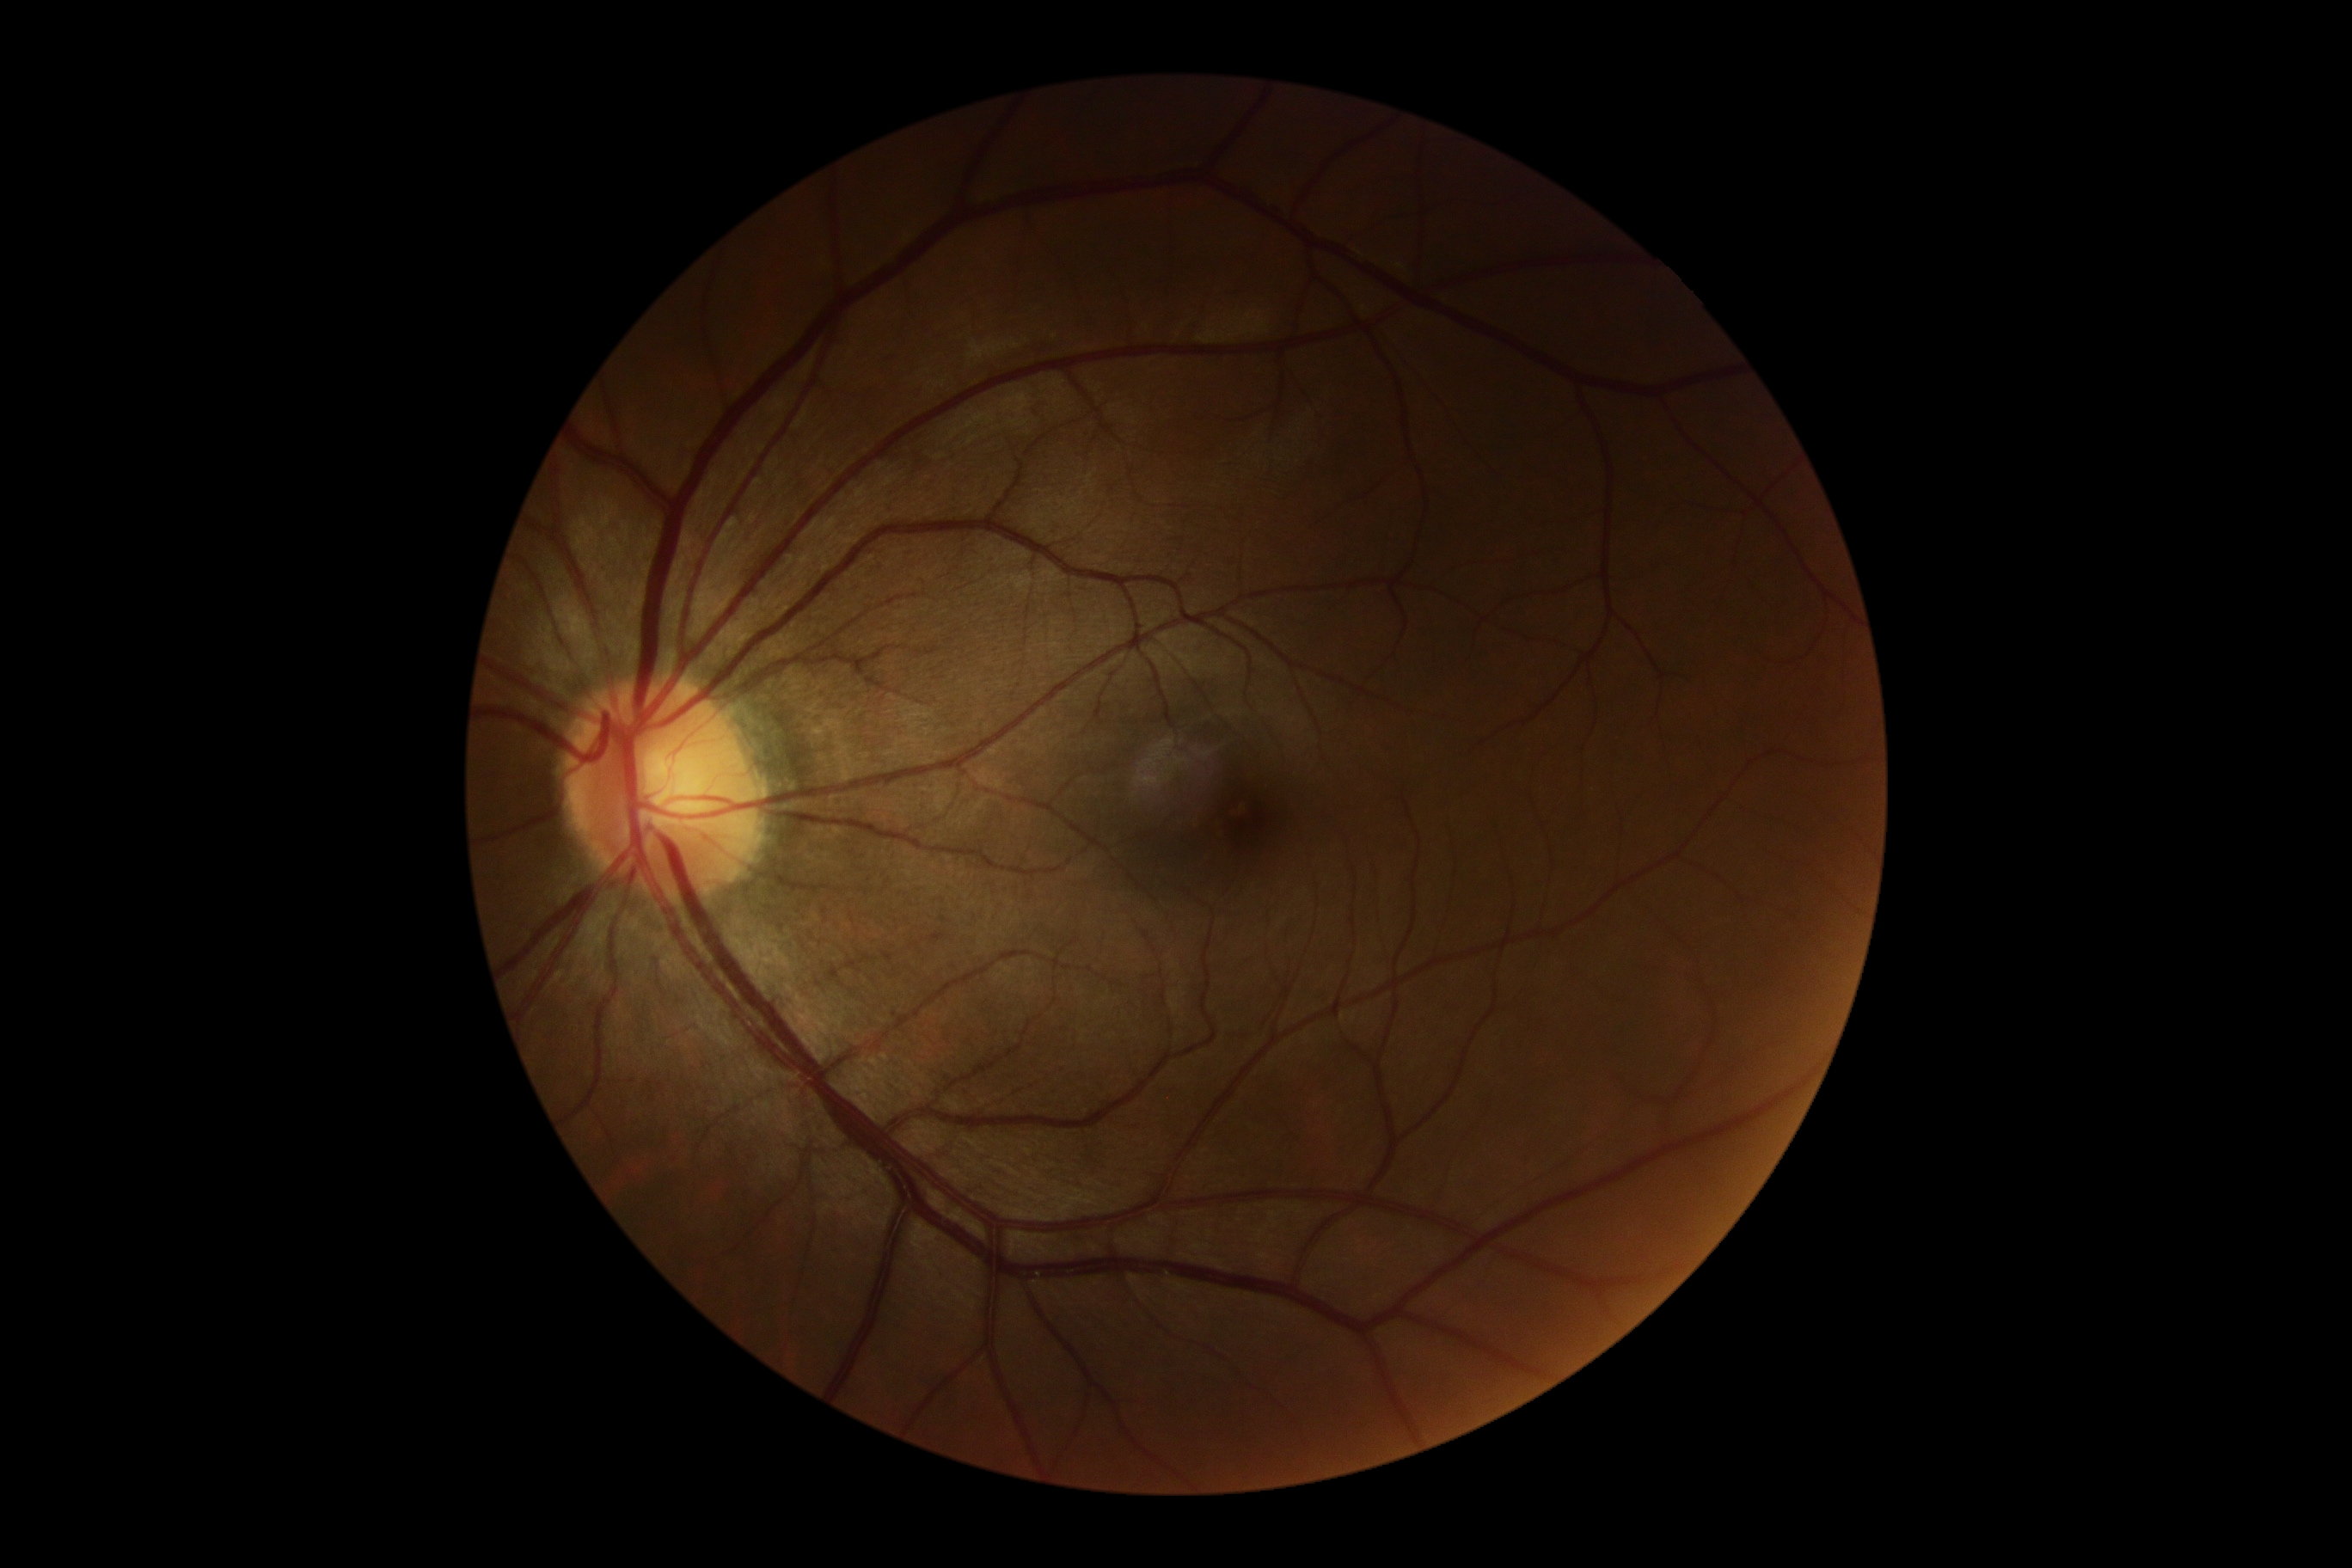

Diabetic retinopathy severity: 0.